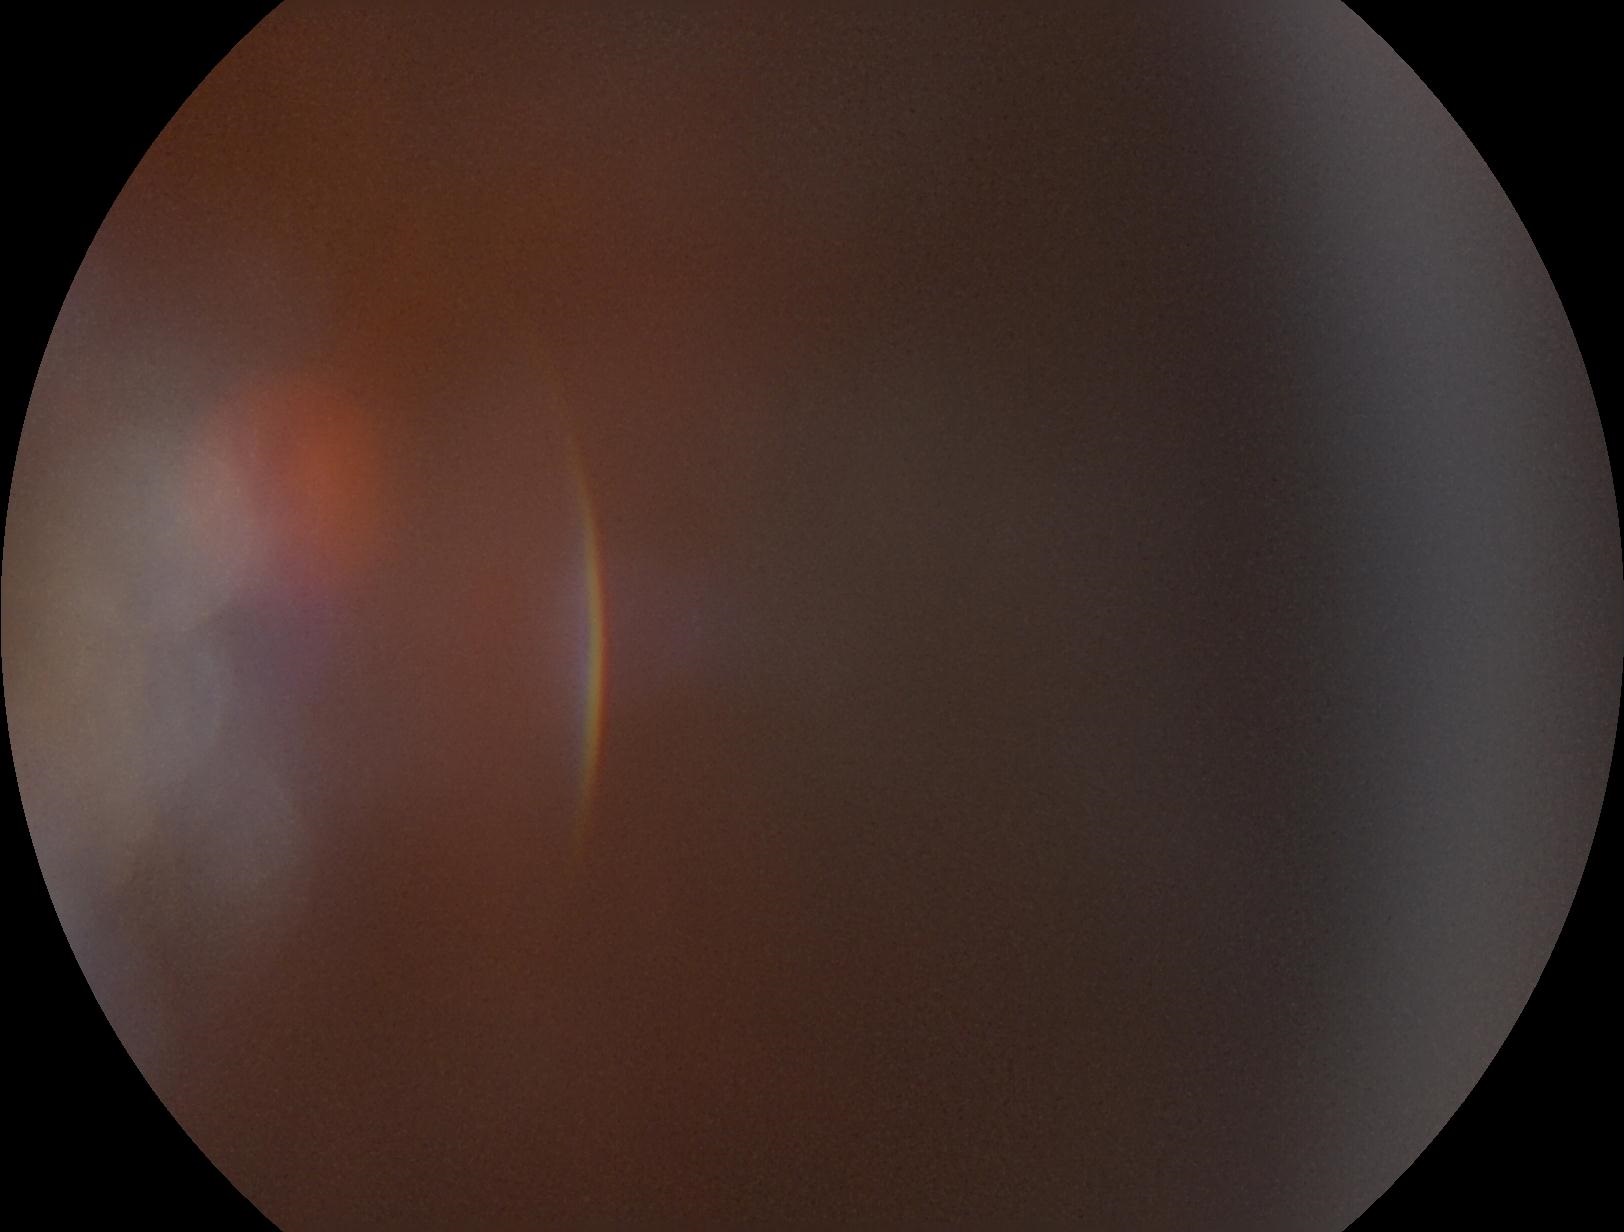
{
  "dr_grade": "ungradable"
}